Fundus photo. 45-degree field of view. Davis DR grading. Acquired with a NIDEK AFC-230. Image size 848x848 — 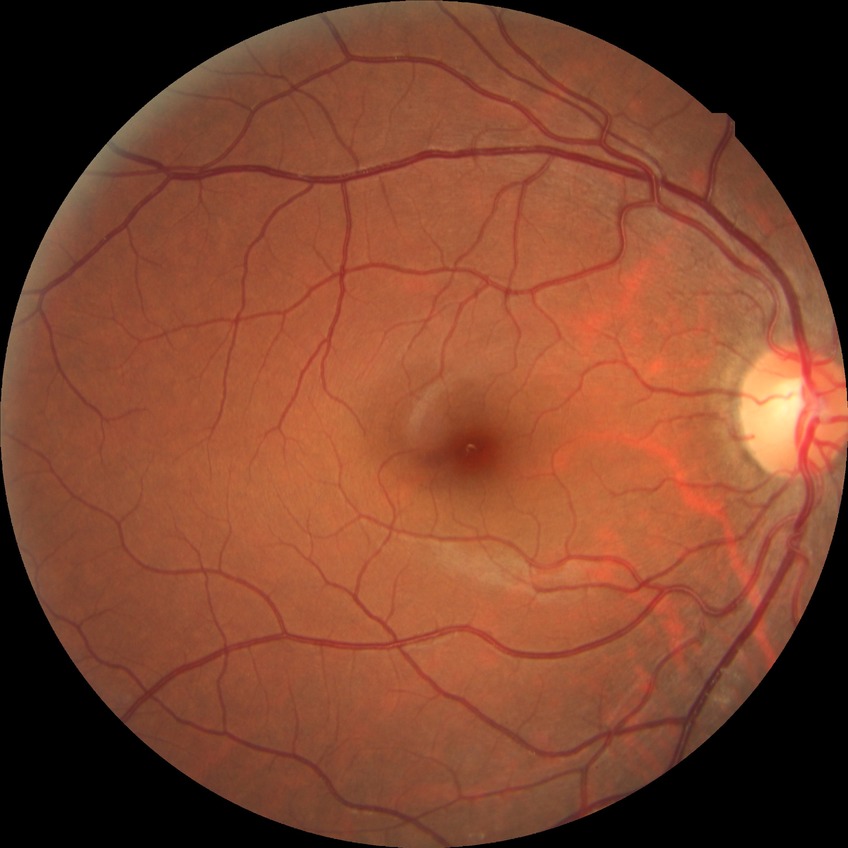

Modified Davis grading is no diabetic retinopathy.